Image size 848x848, CFP, NIDEK AFC-230 fundus camera, nonmydriatic fundus photograph, FOV: 45 degrees — 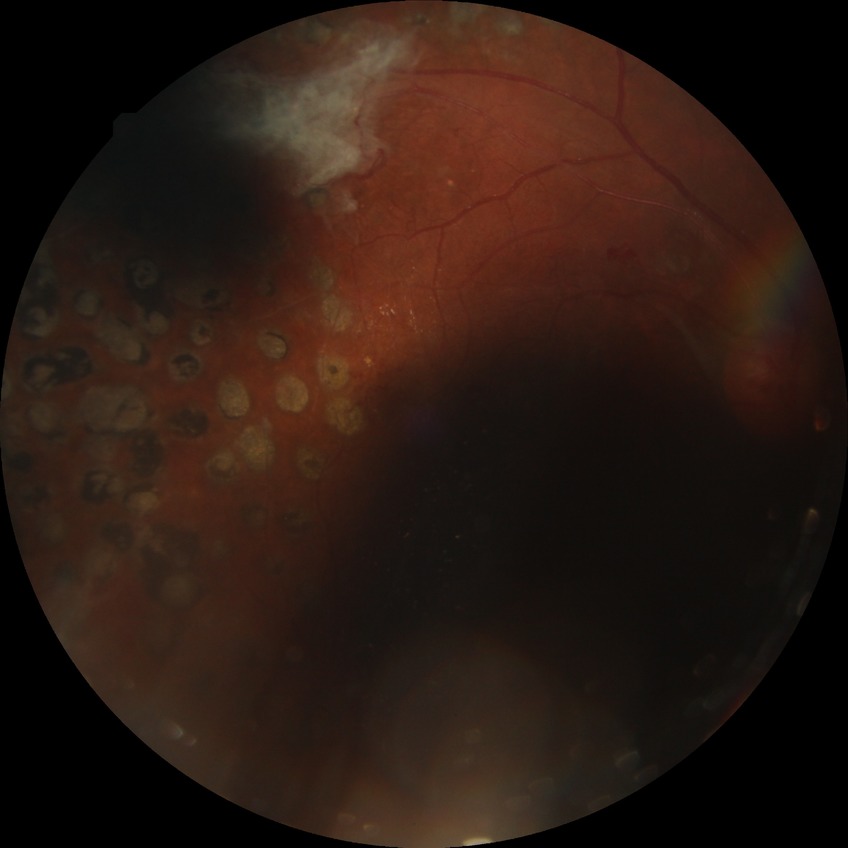

Diabetic retinopathy (DR): PDR (proliferative diabetic retinopathy).